240 by 240 pixels:
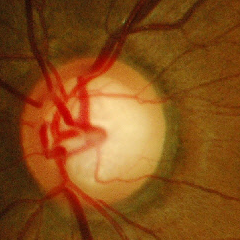

Glaucoma is present.
Early glaucoma.